Retinal fundus photograph; FOV: 45 degrees — 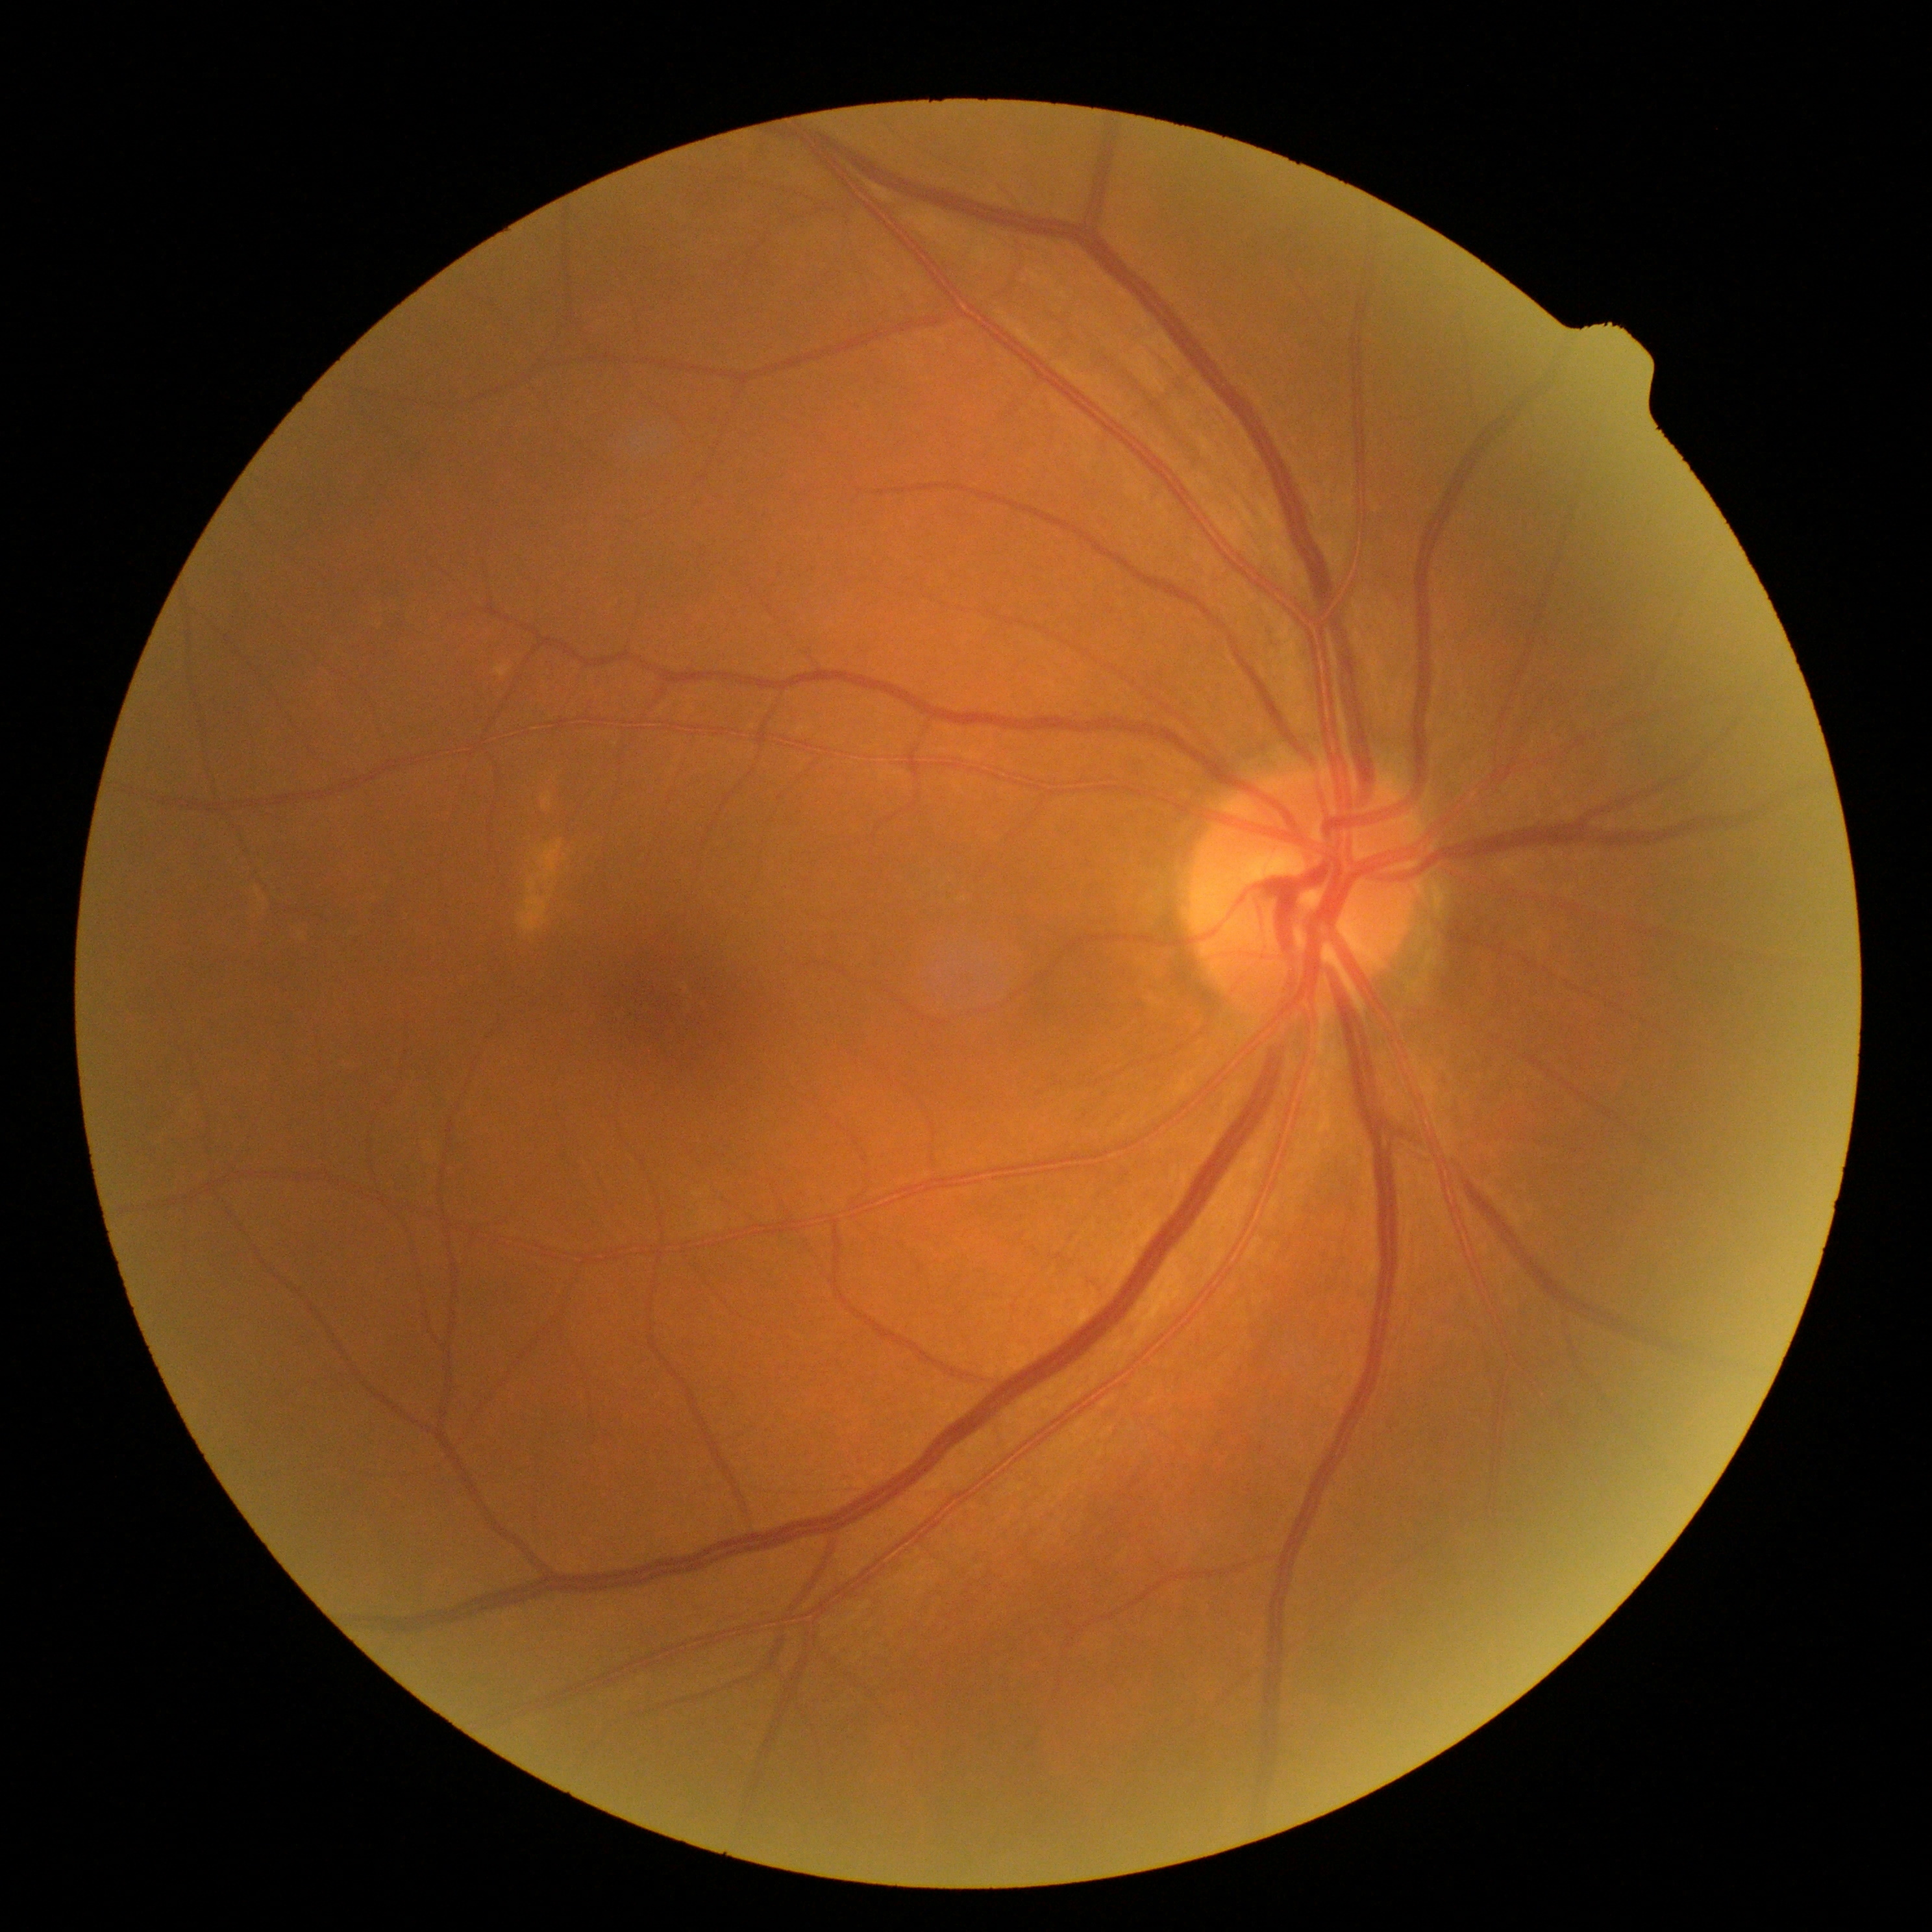
dr_grade: grade 0 (no apparent retinopathy) — no visible signs of diabetic retinopathy